CFP.
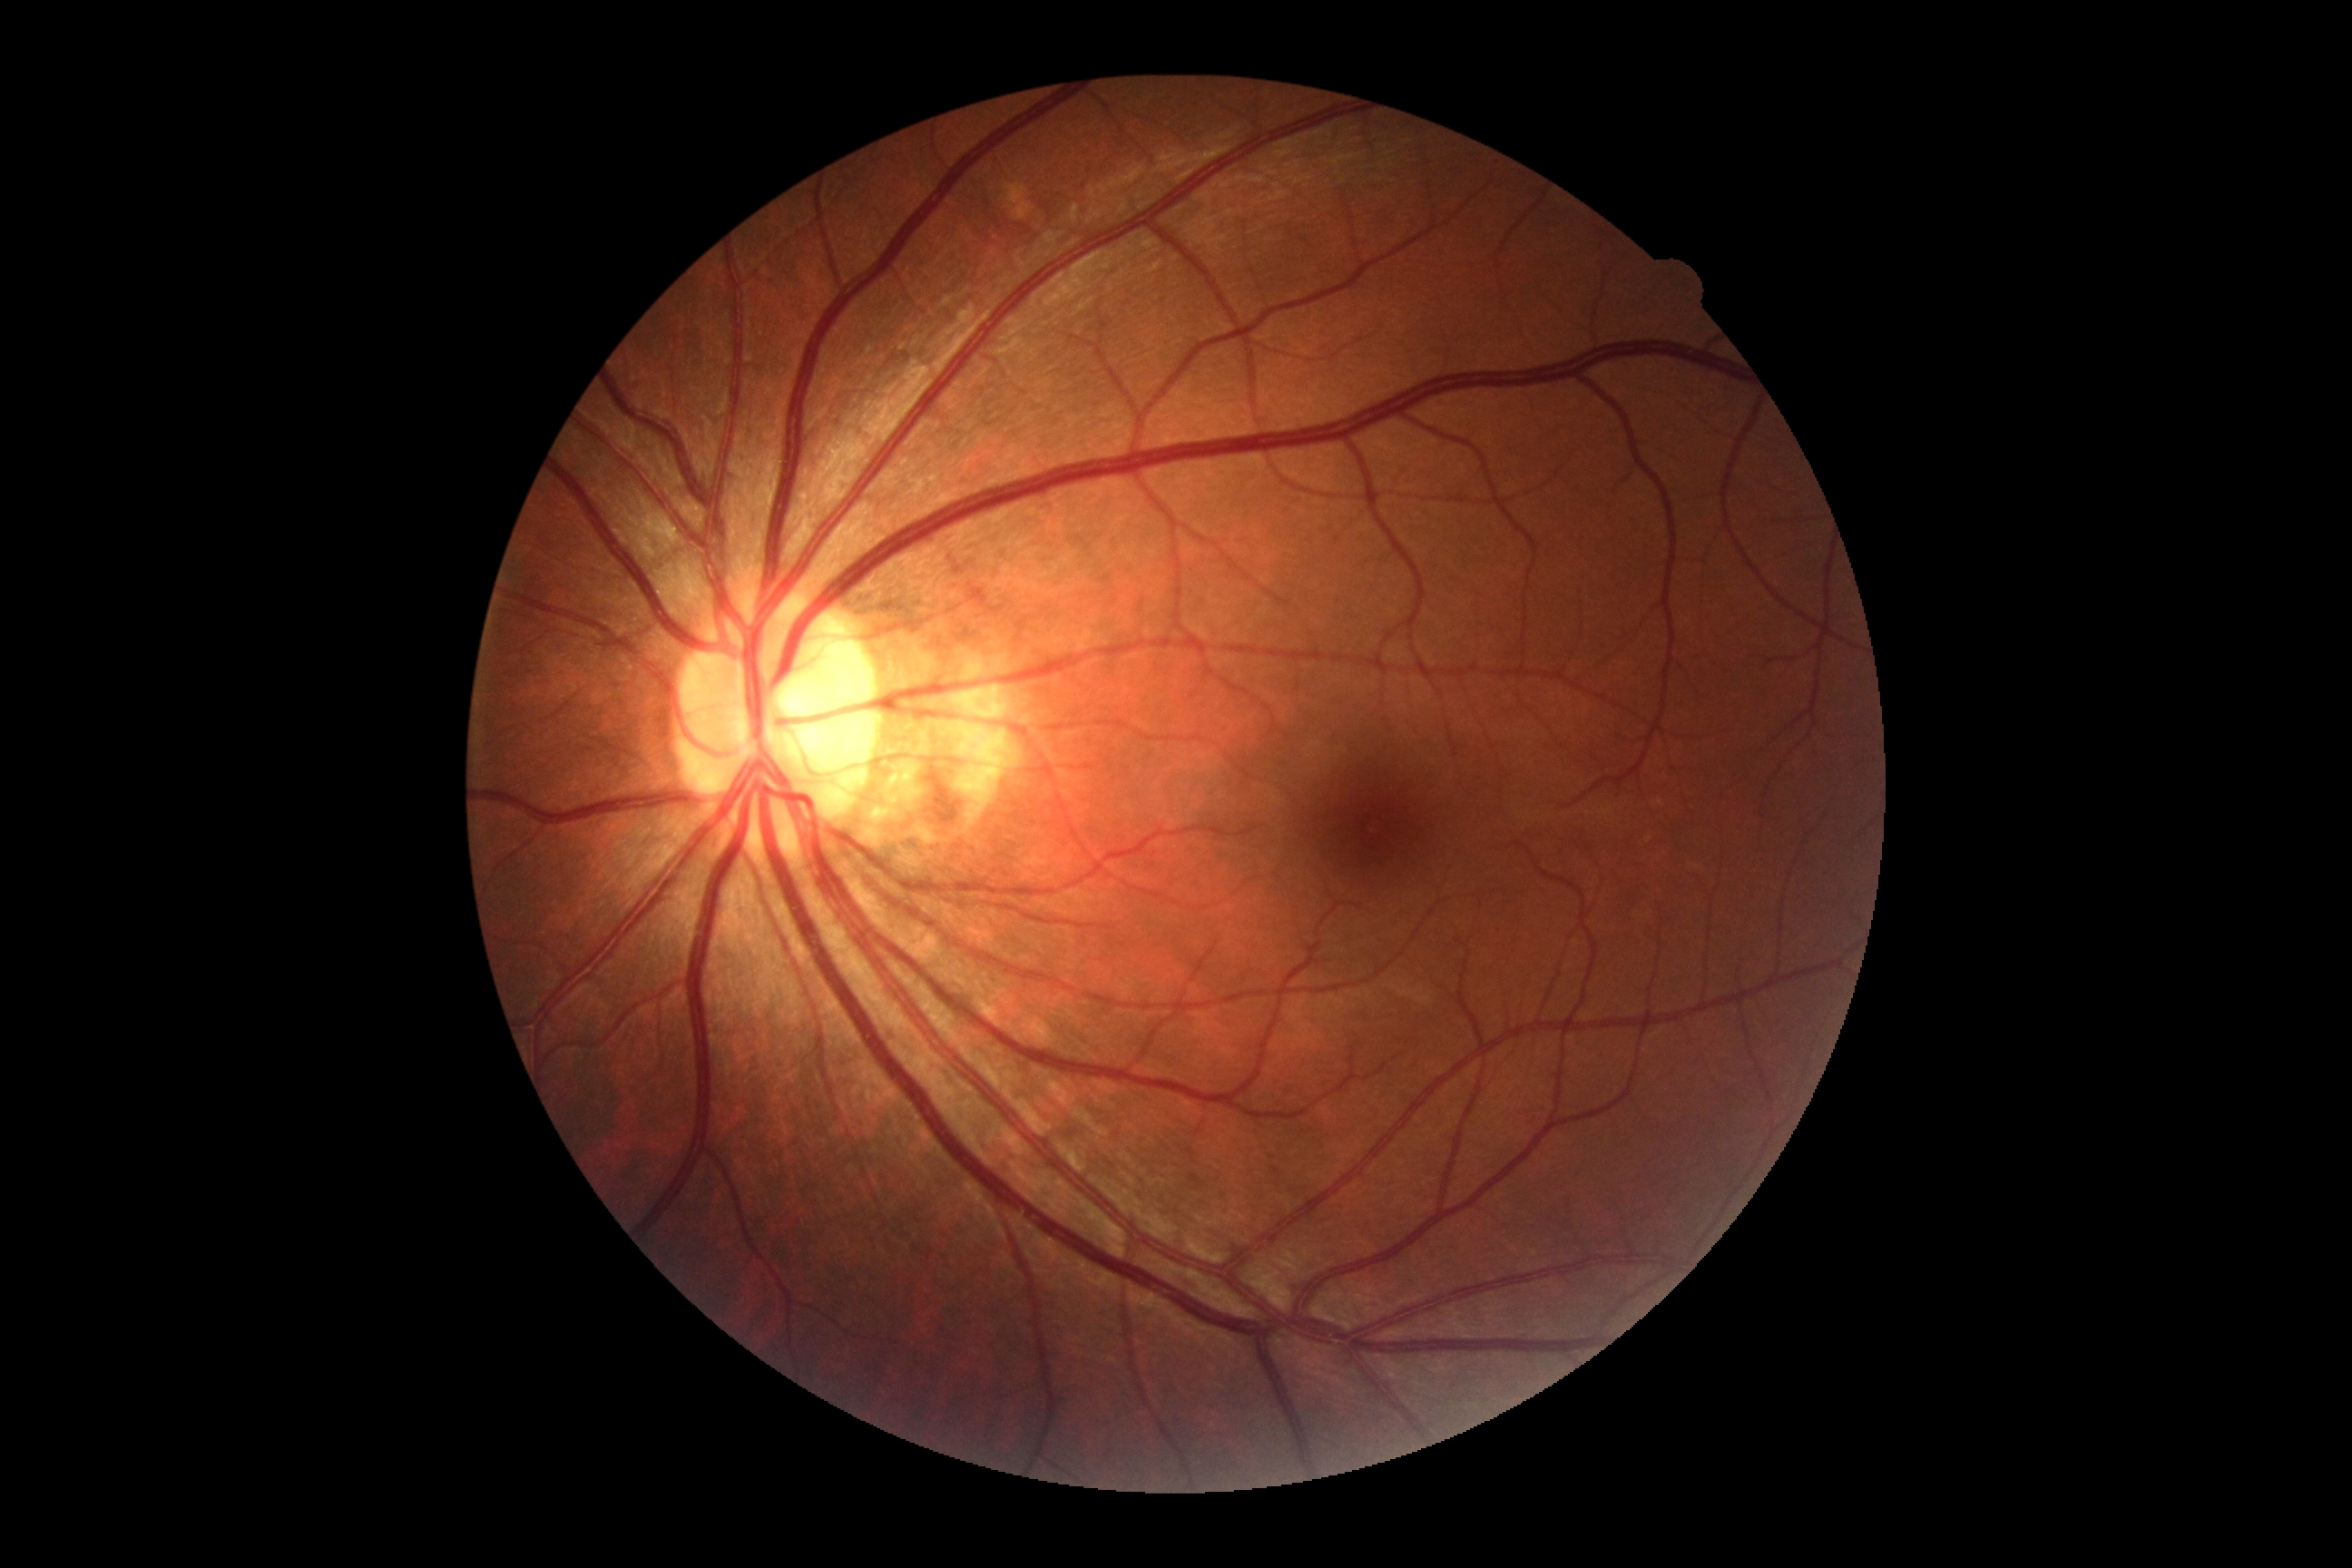 DR stage: 0. No signs of diabetic retinopathy.